Retinal fundus photograph; 2212x1659; 45-degree field of view — 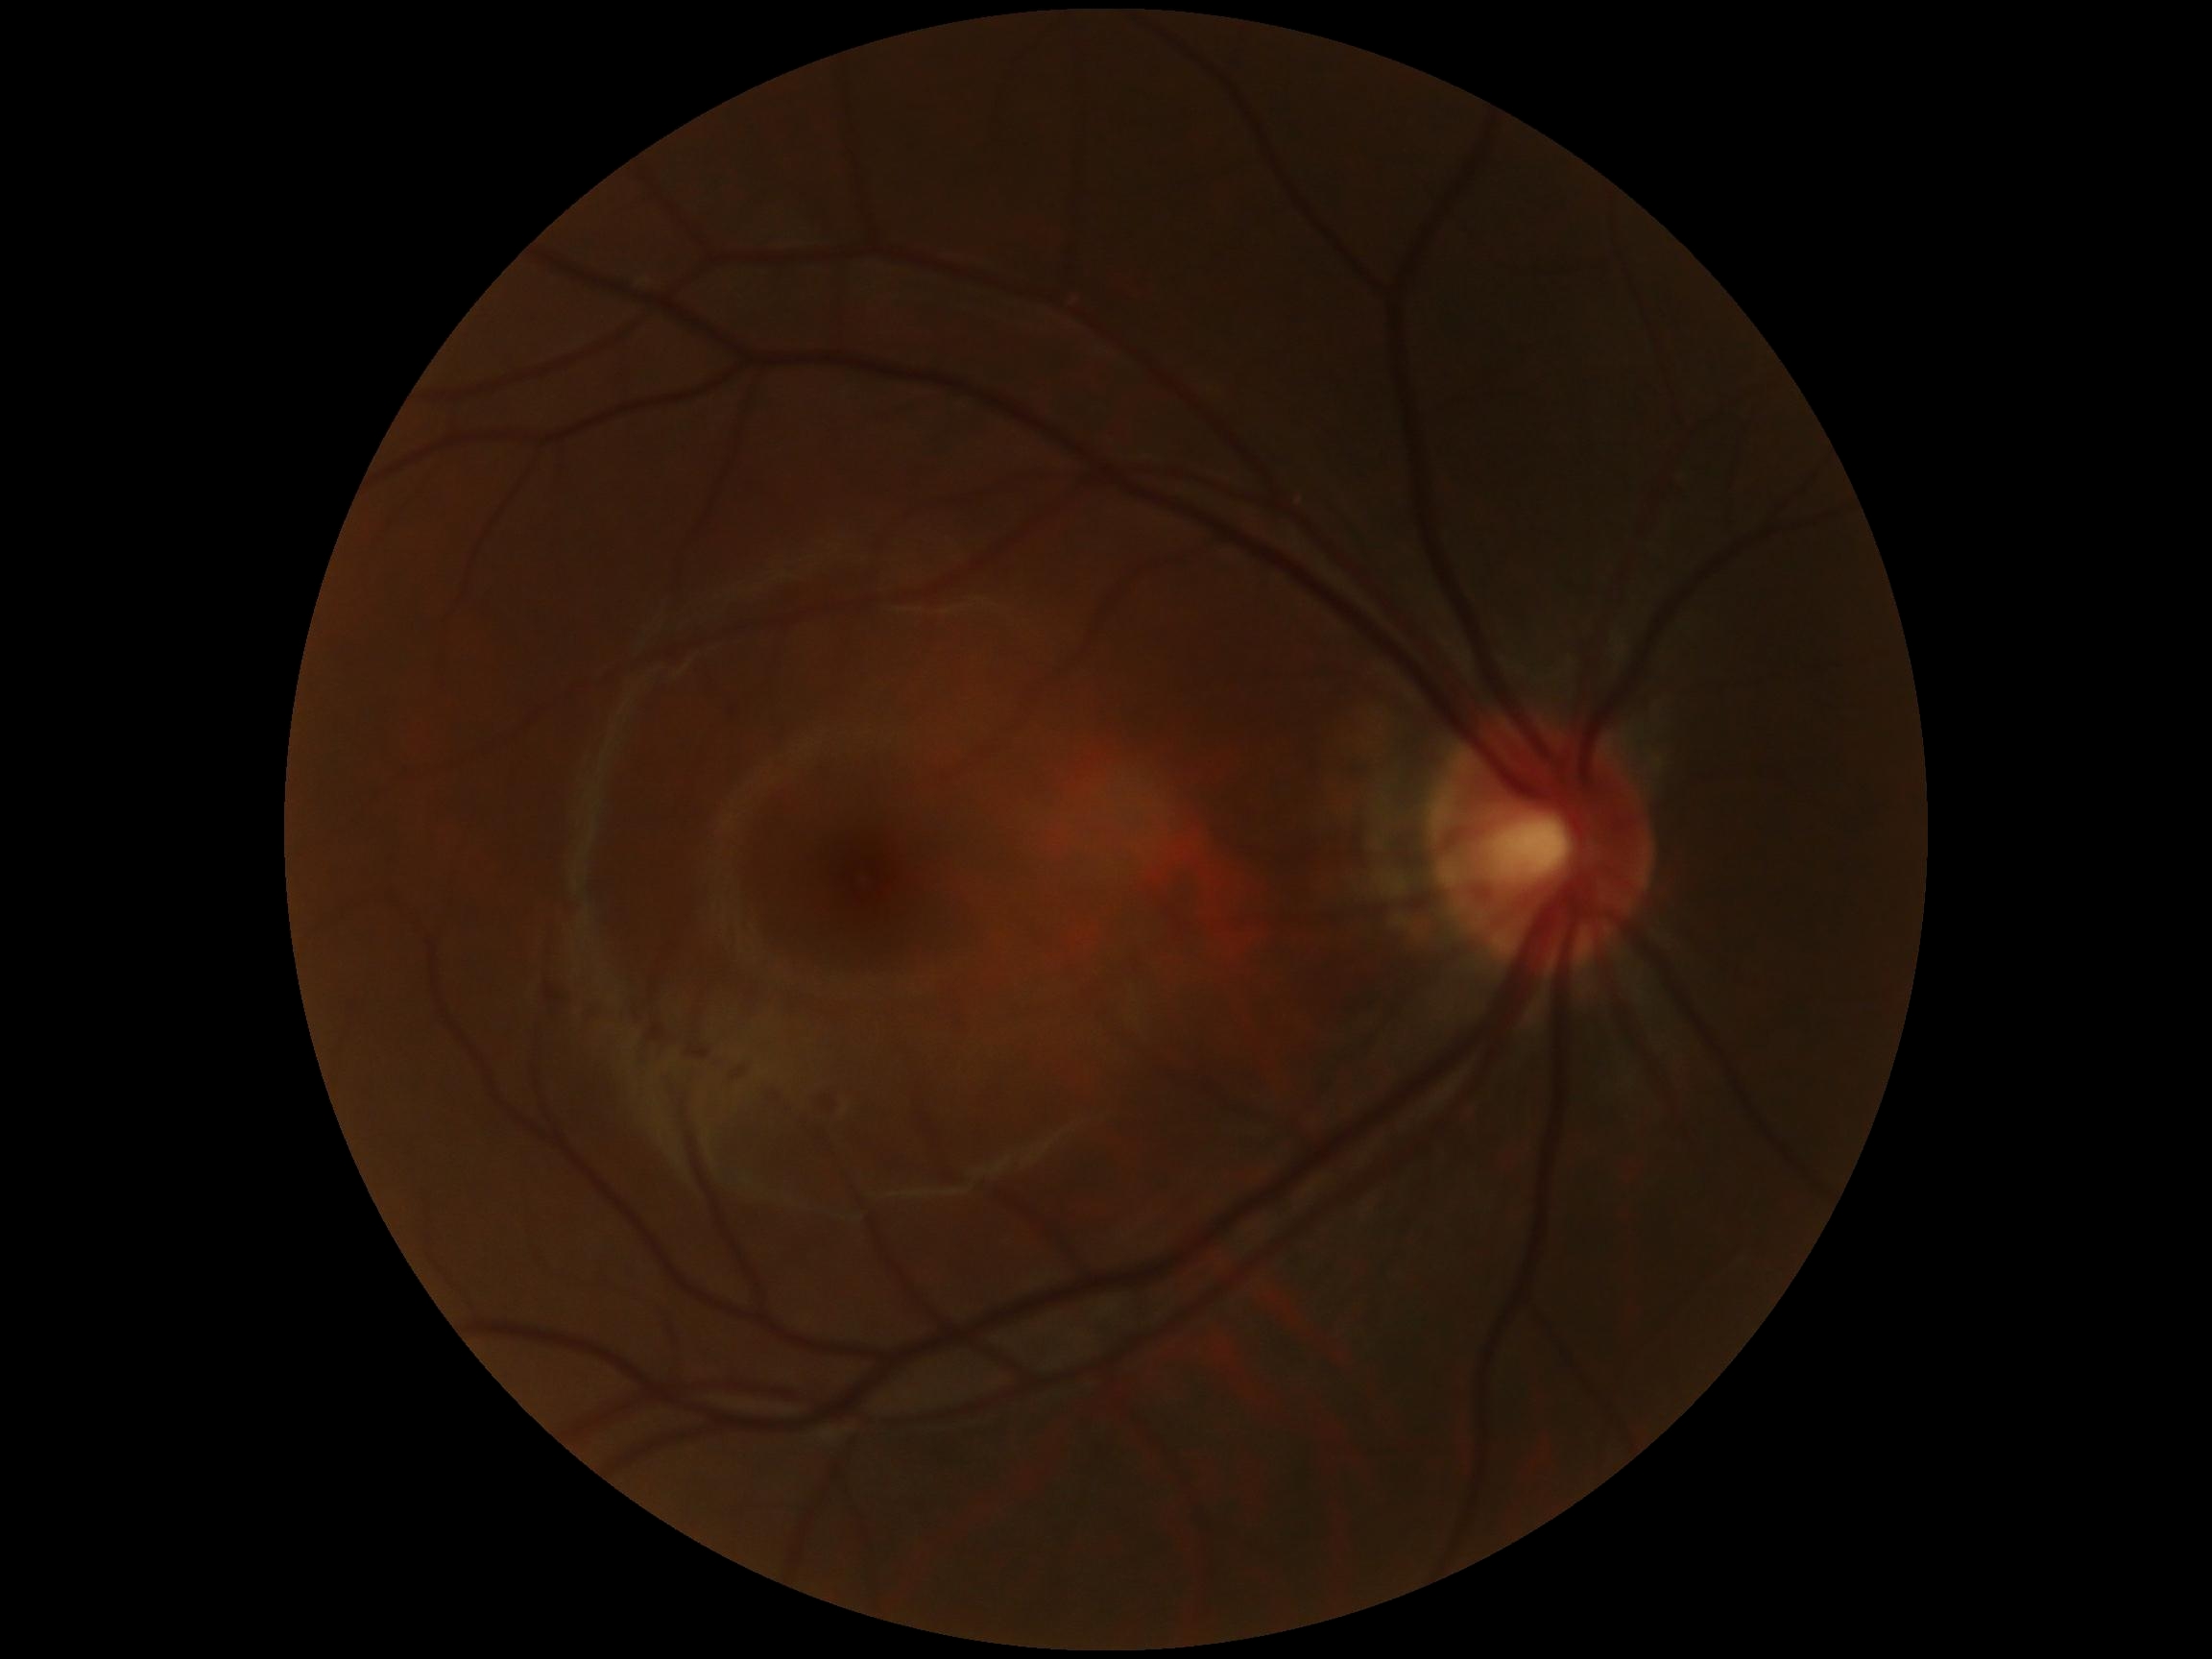 DR severity: grade 0.